1240x1240 · infant wide-field retinal image · captured with the Phoenix ICON (100° field of view): 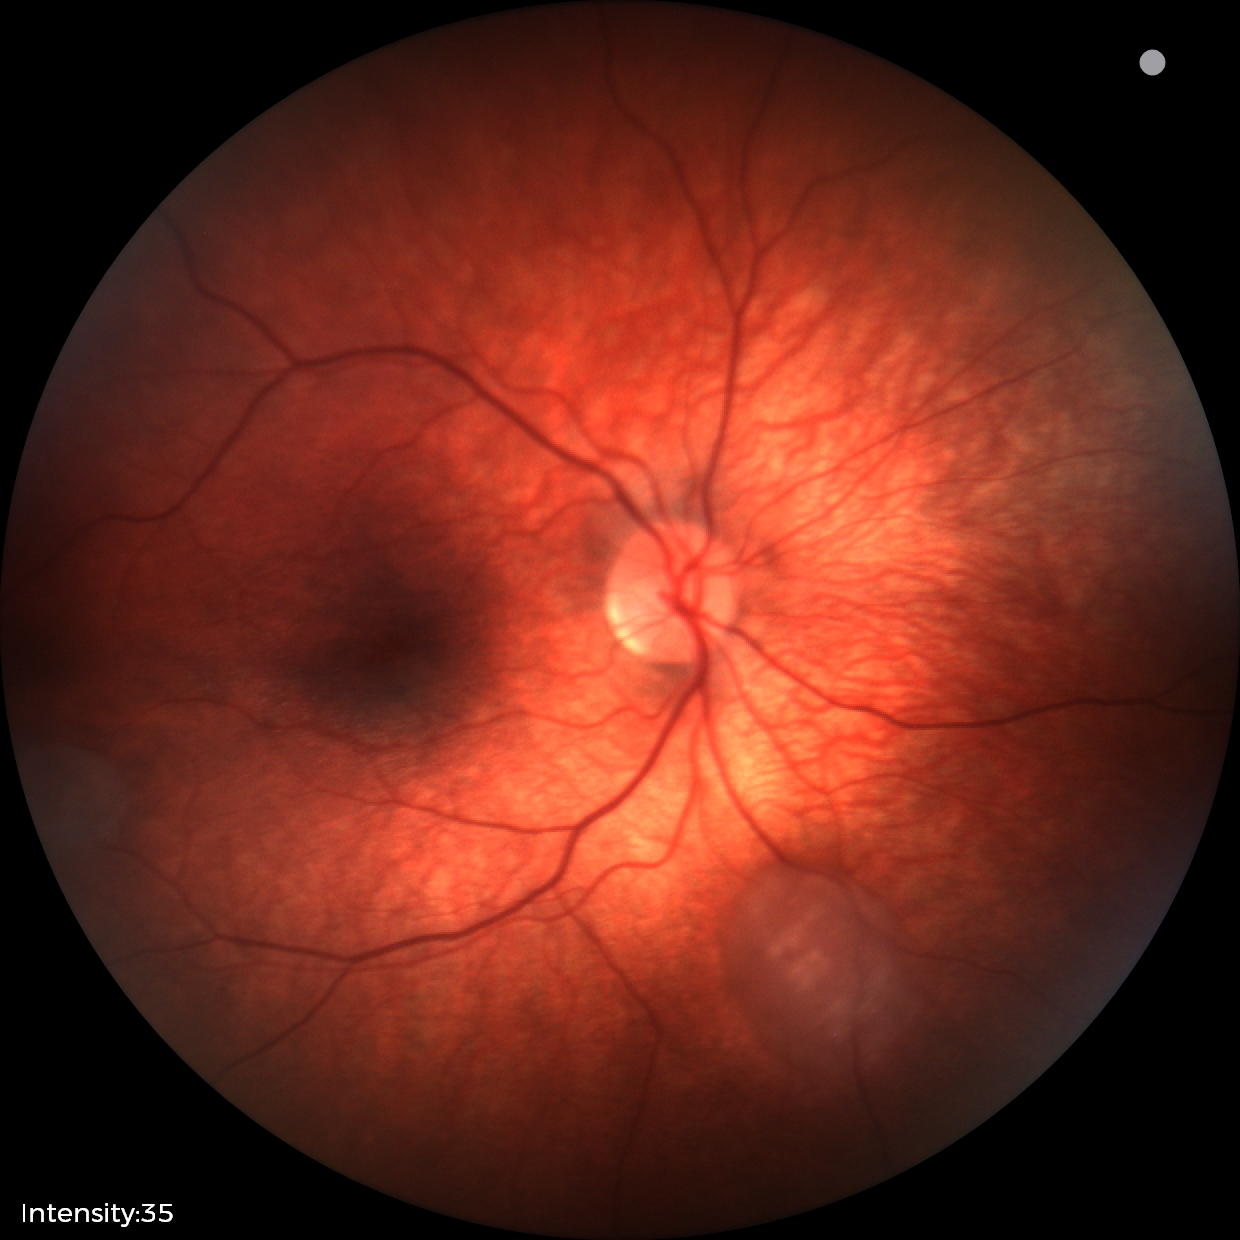

Examination diagnosed as retinal astrocytic hamartoma.